Ultra-widefield fundus mosaic · 200-degree field of view — 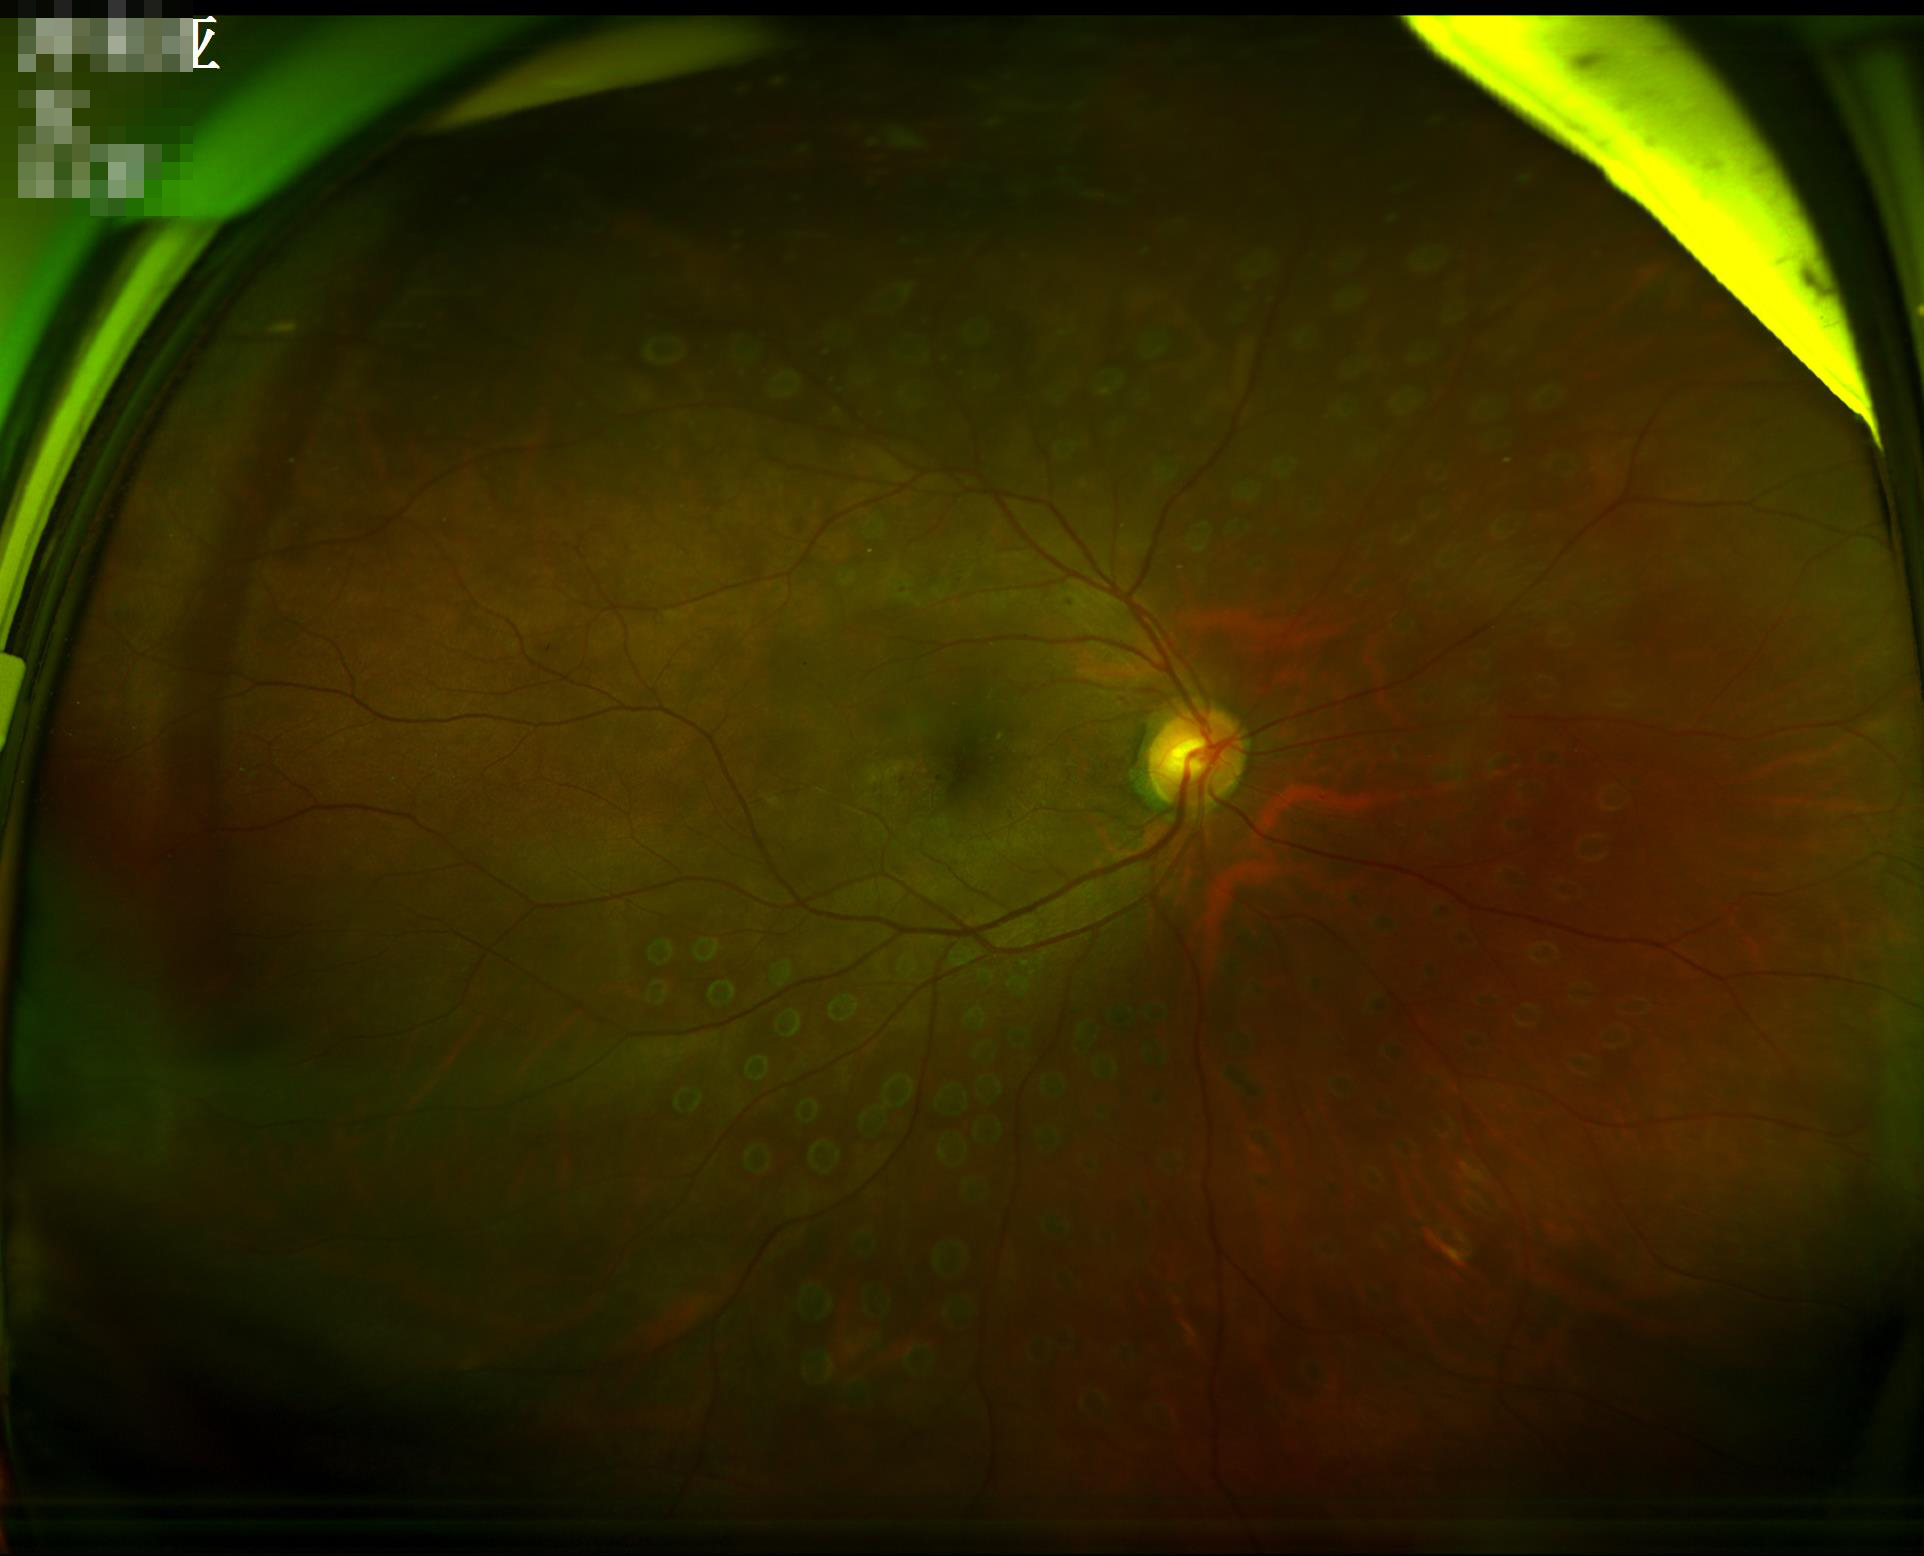
{"illumination": "satisfactory", "contrast": "adequate", "overall_quality": "good", "clarity": "reduced"}